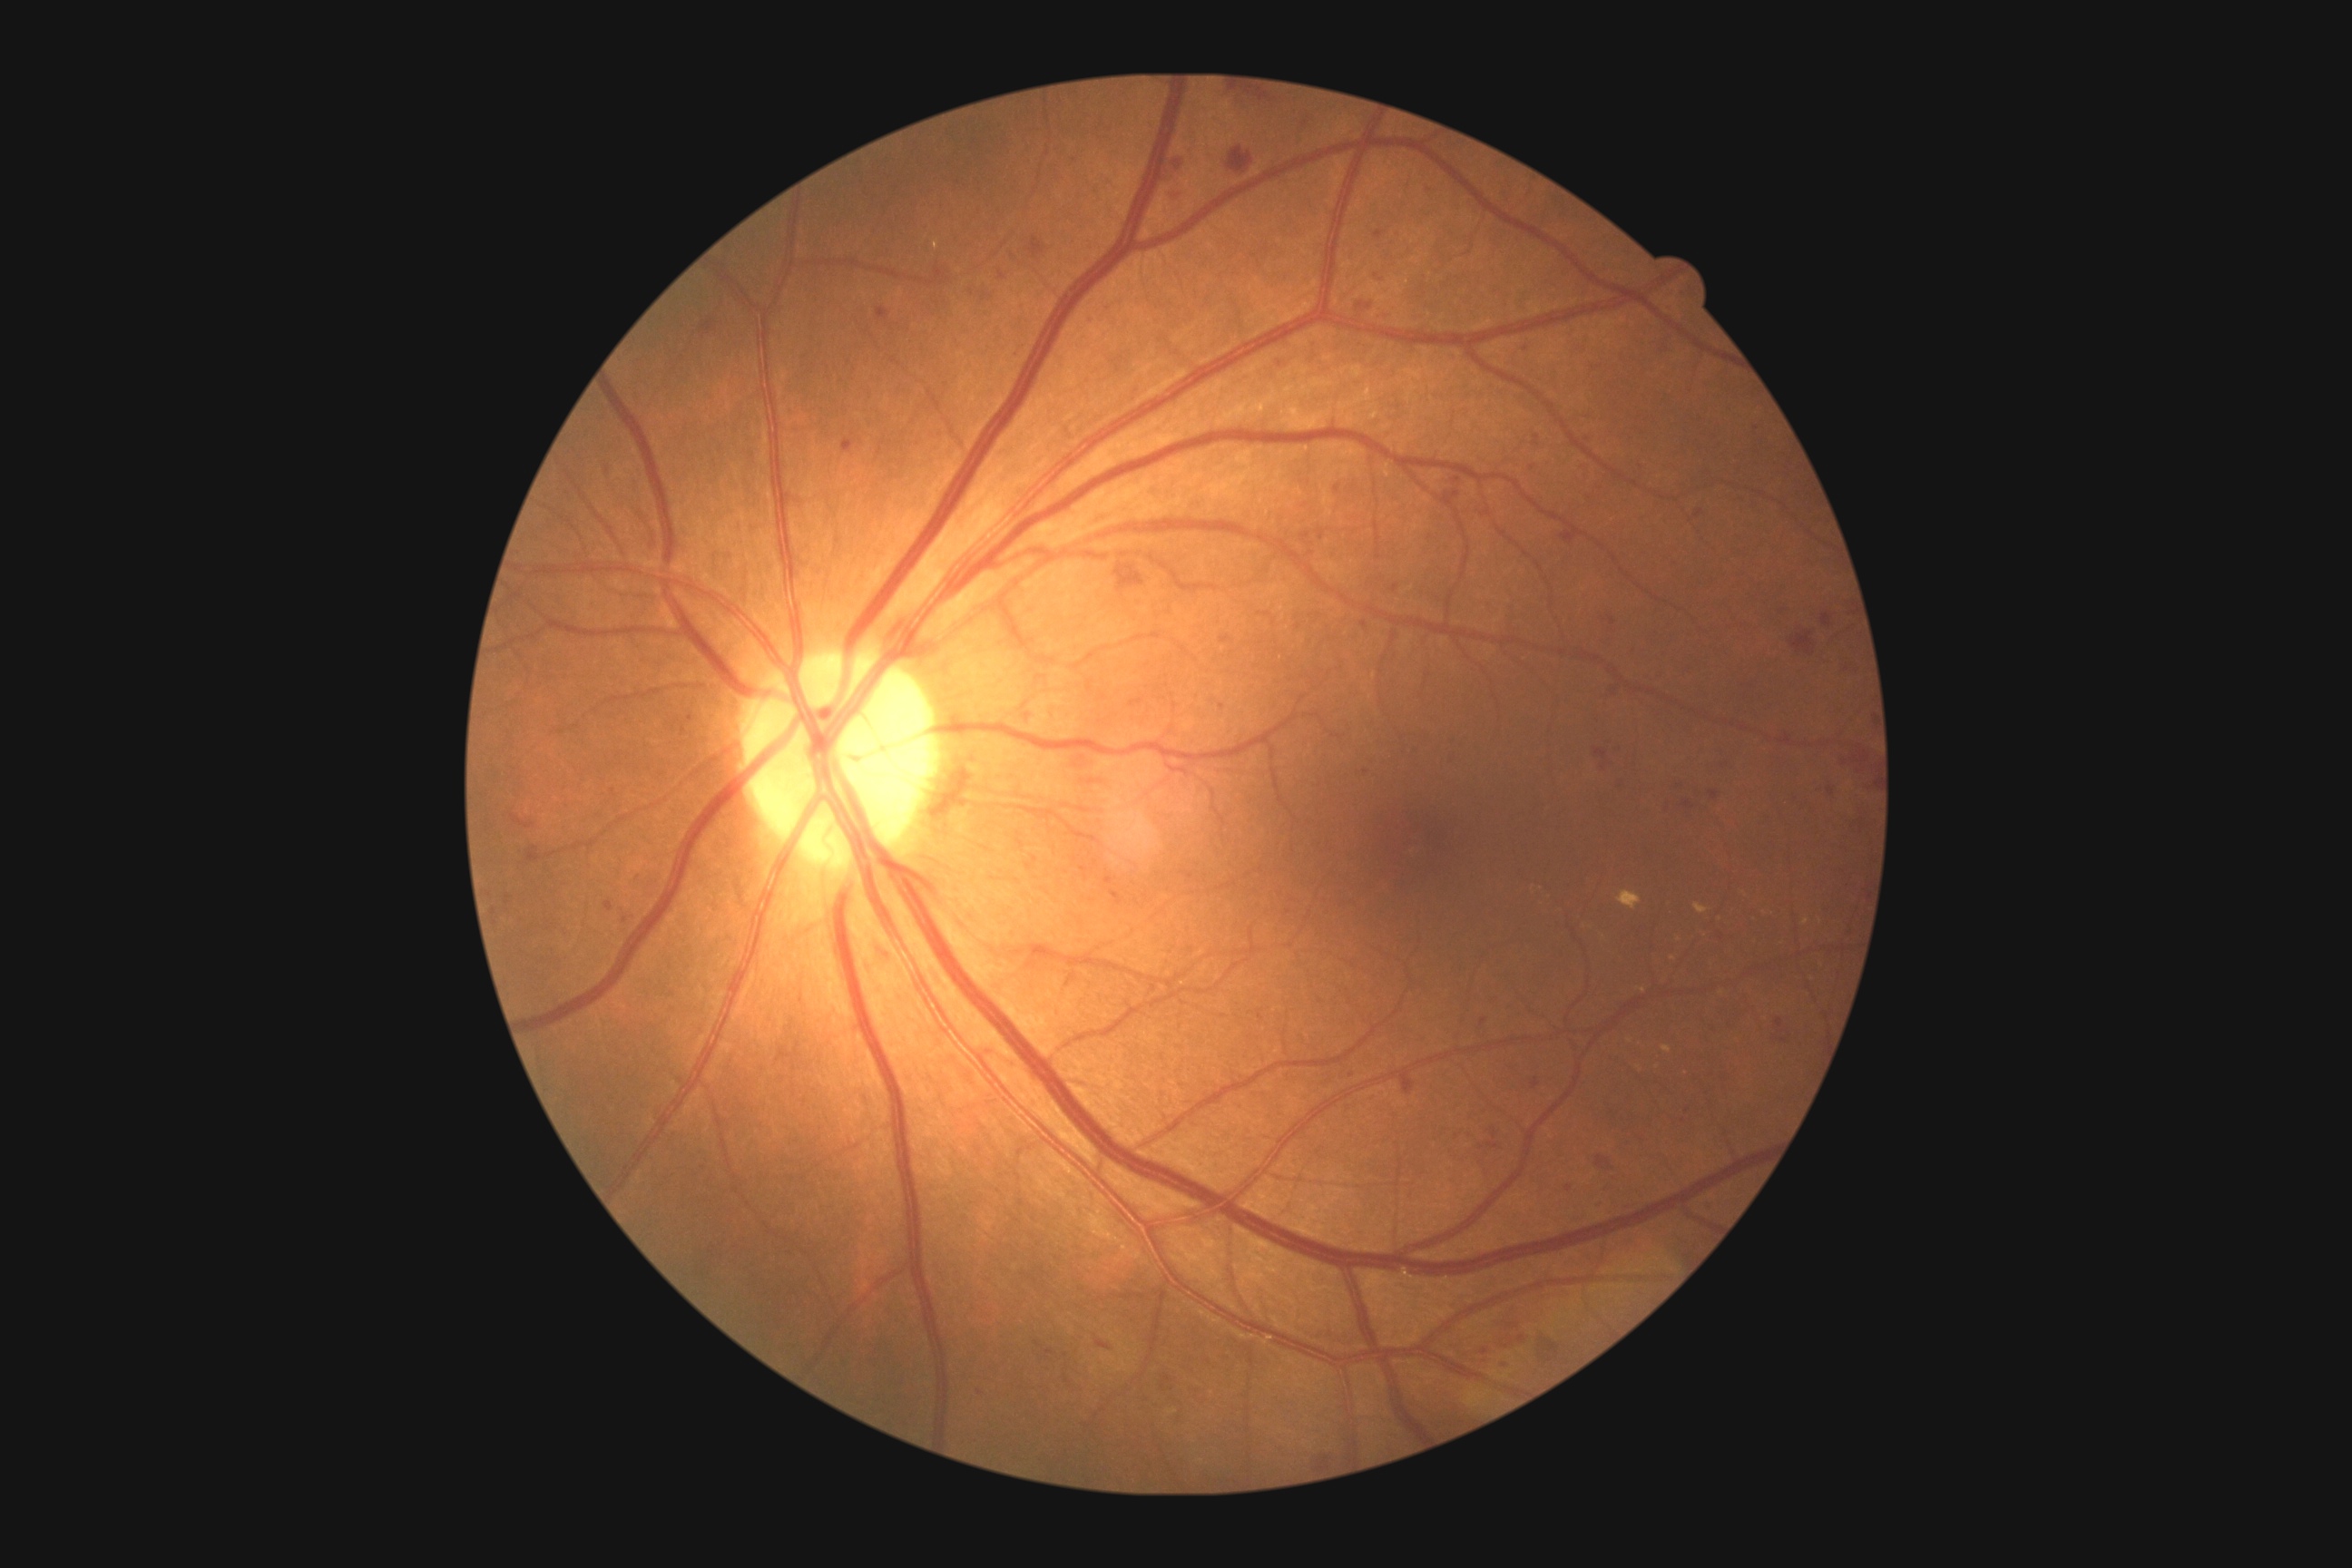 Diabetic retinopathy (DR) is grade 2 (moderate NPDR).
Hemorrhages (HEs) (partial list) at 1671,562,1680,567 | 1073,774,1112,789 | 1611,778,1625,789 | 1308,1447,1338,1469 | 1841,596,1852,616 | 1531,431,1542,447 | 1318,531,1326,542 | 1823,614,1832,627 | 1493,1322,1533,1351 | 1565,1184,1573,1193 | 1636,464,1647,473 | 1300,533,1311,544 | 1774,603,1794,618 | 511,814,534,830 | 687,714,692,723.
Small HEs approximately at pt(1484, 1022) | pt(1075, 859) | pt(1366, 773) | pt(1065, 1355).